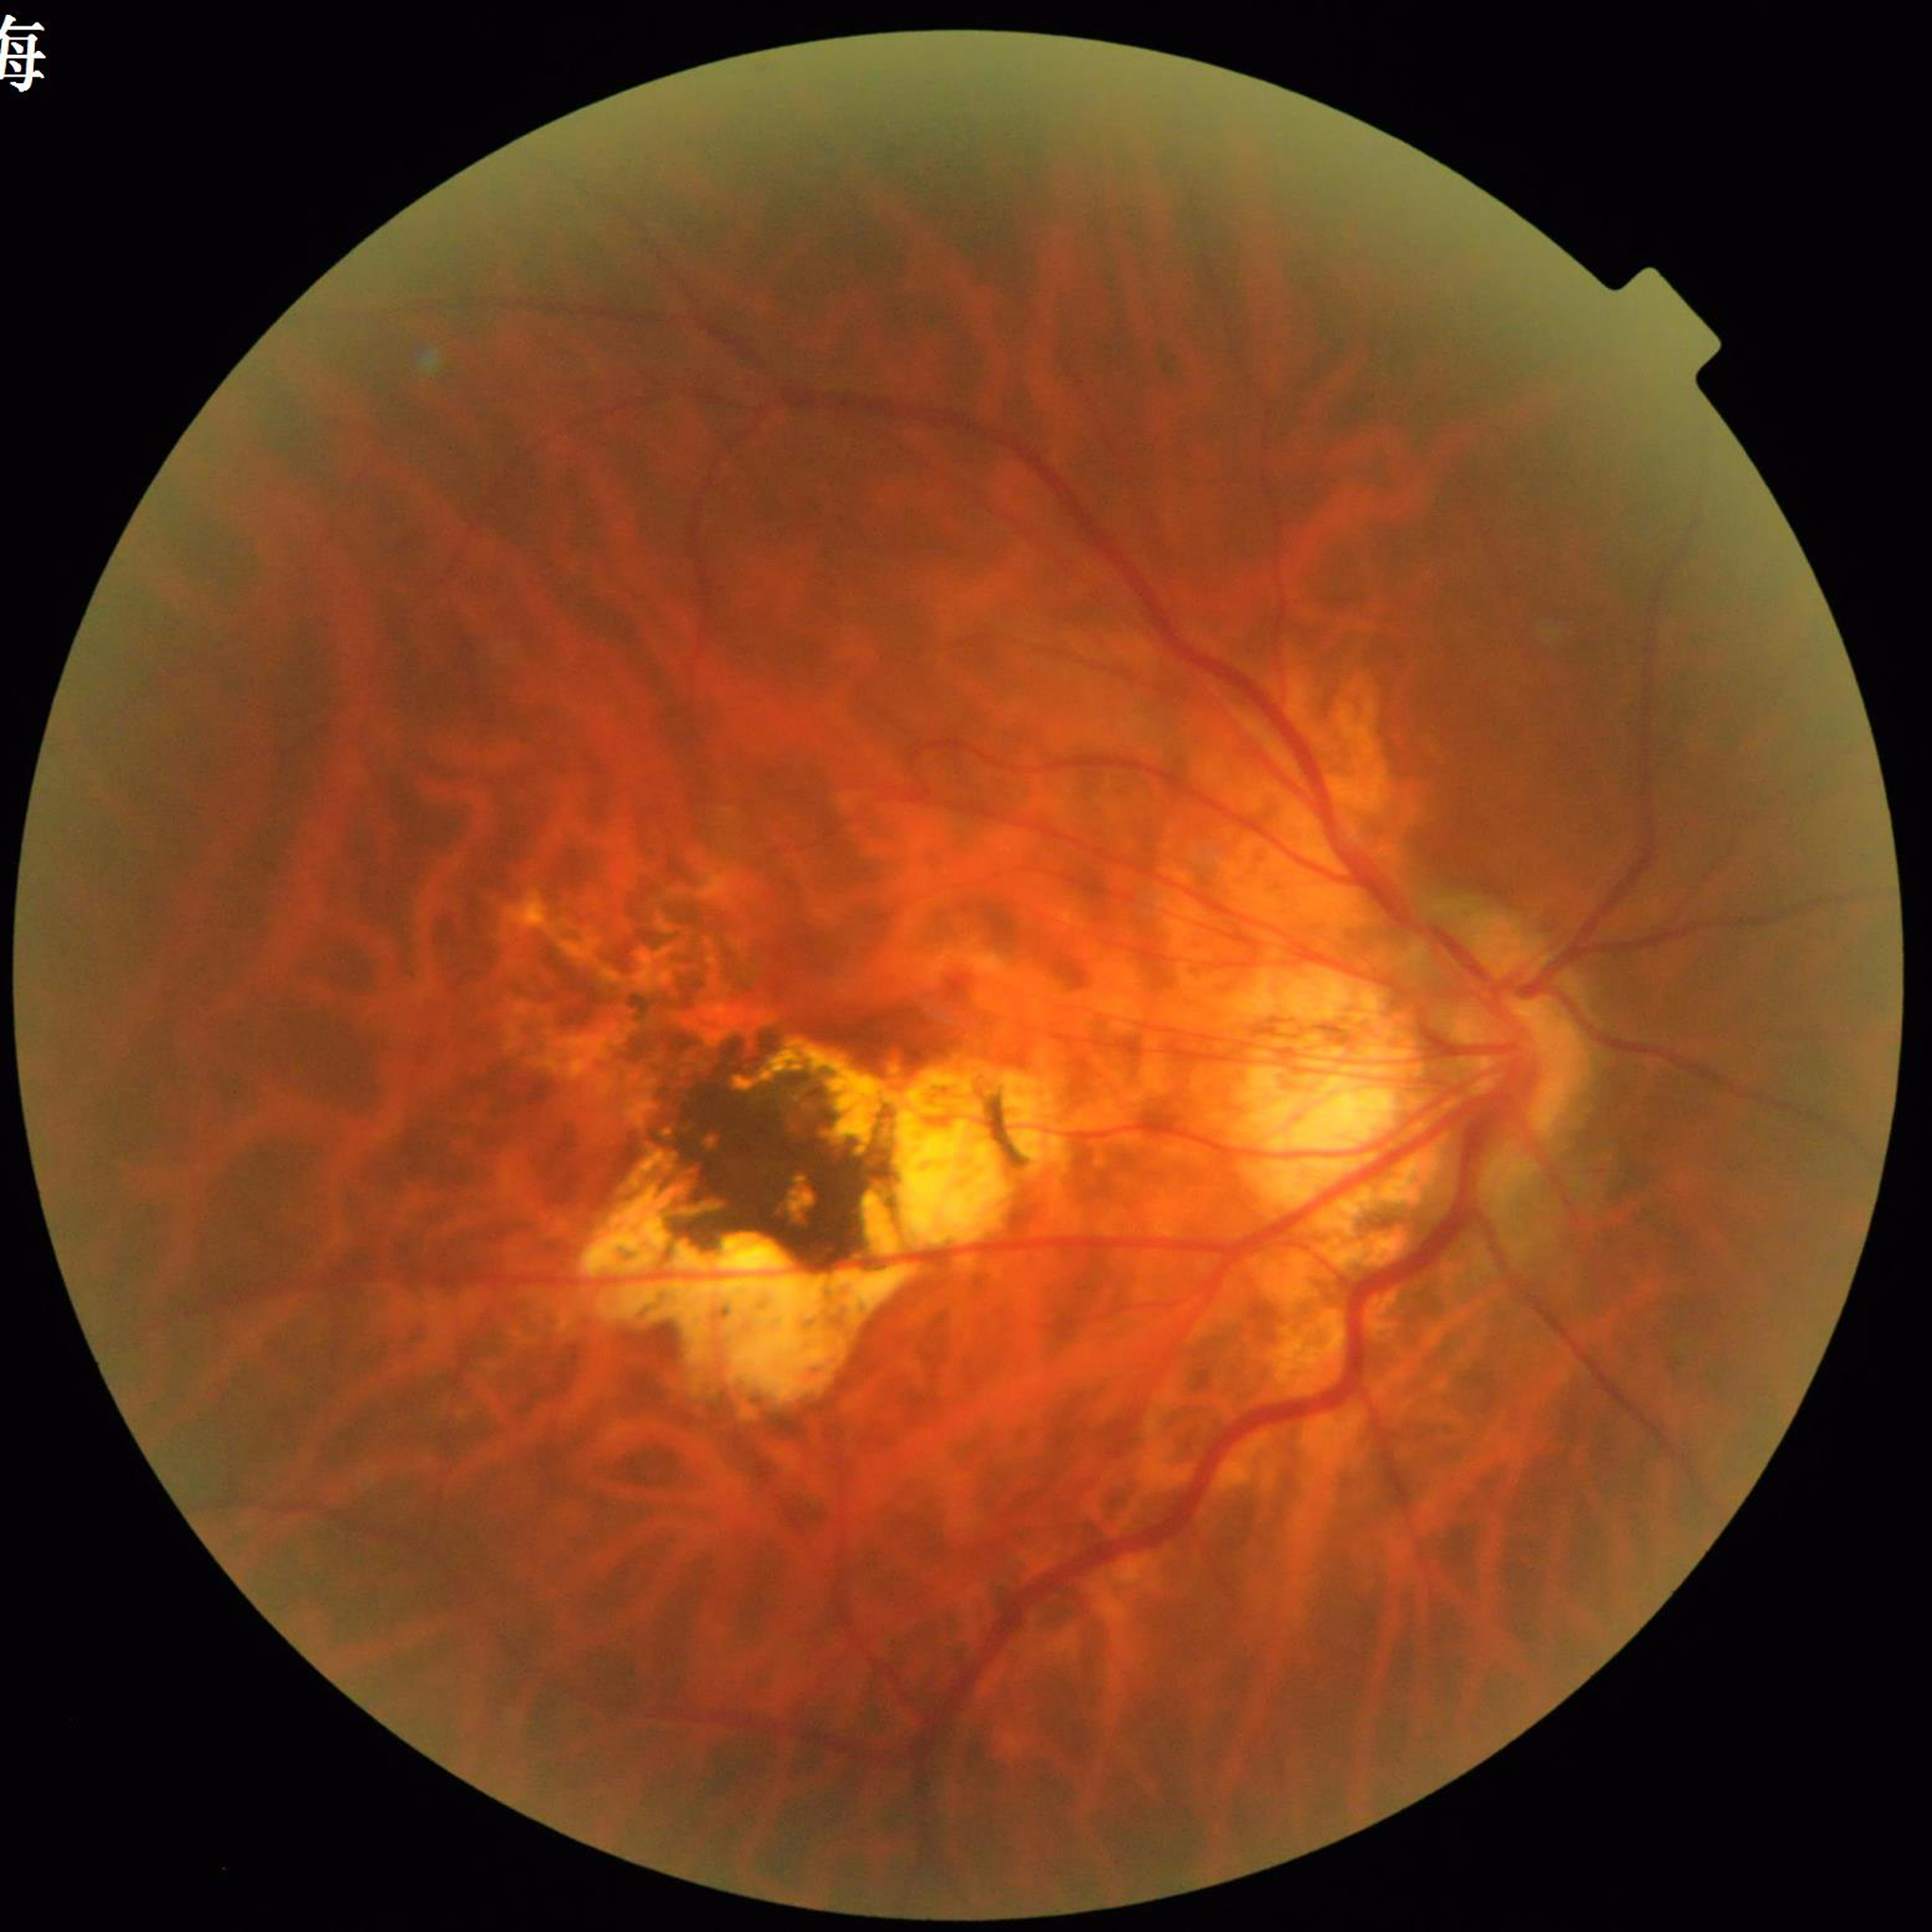
Condition = AMD.